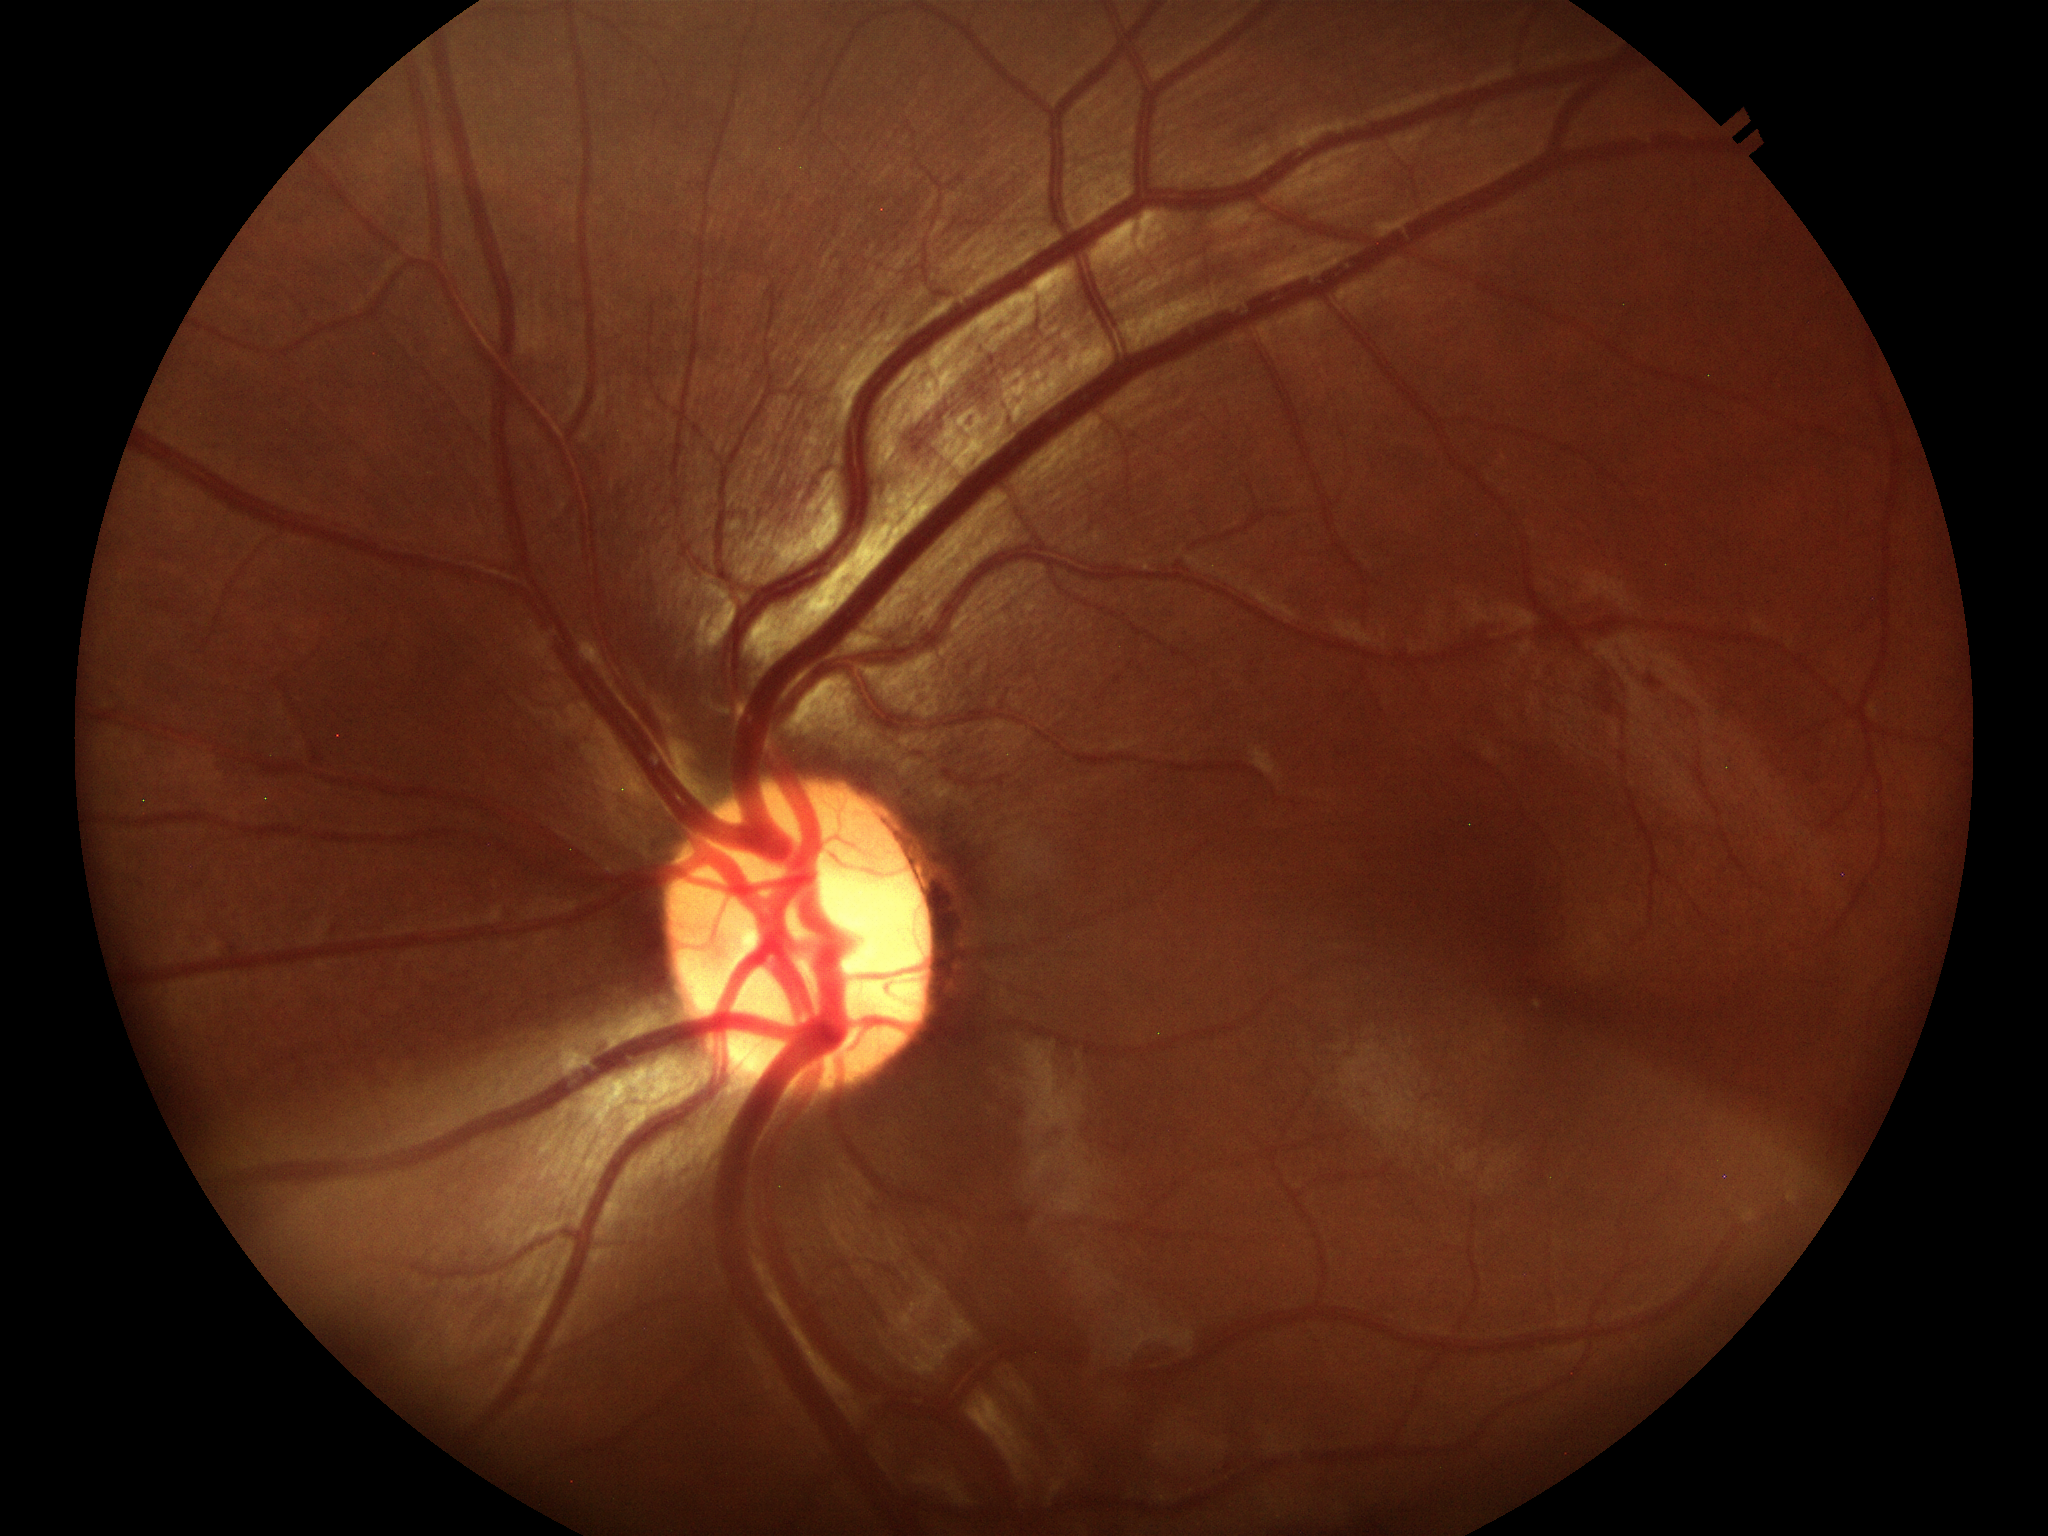

Glaucoma impression: suspicious findings (three of five ophthalmologists flagged glaucoma suspect) | horizontal C/D ratio: 0.58 | vertical cup-to-disc ratio: 0.60